1440x1080px · captured with the Natus RetCam Envision (130° field of view) · wide-field fundus photograph from neonatal ROP screening
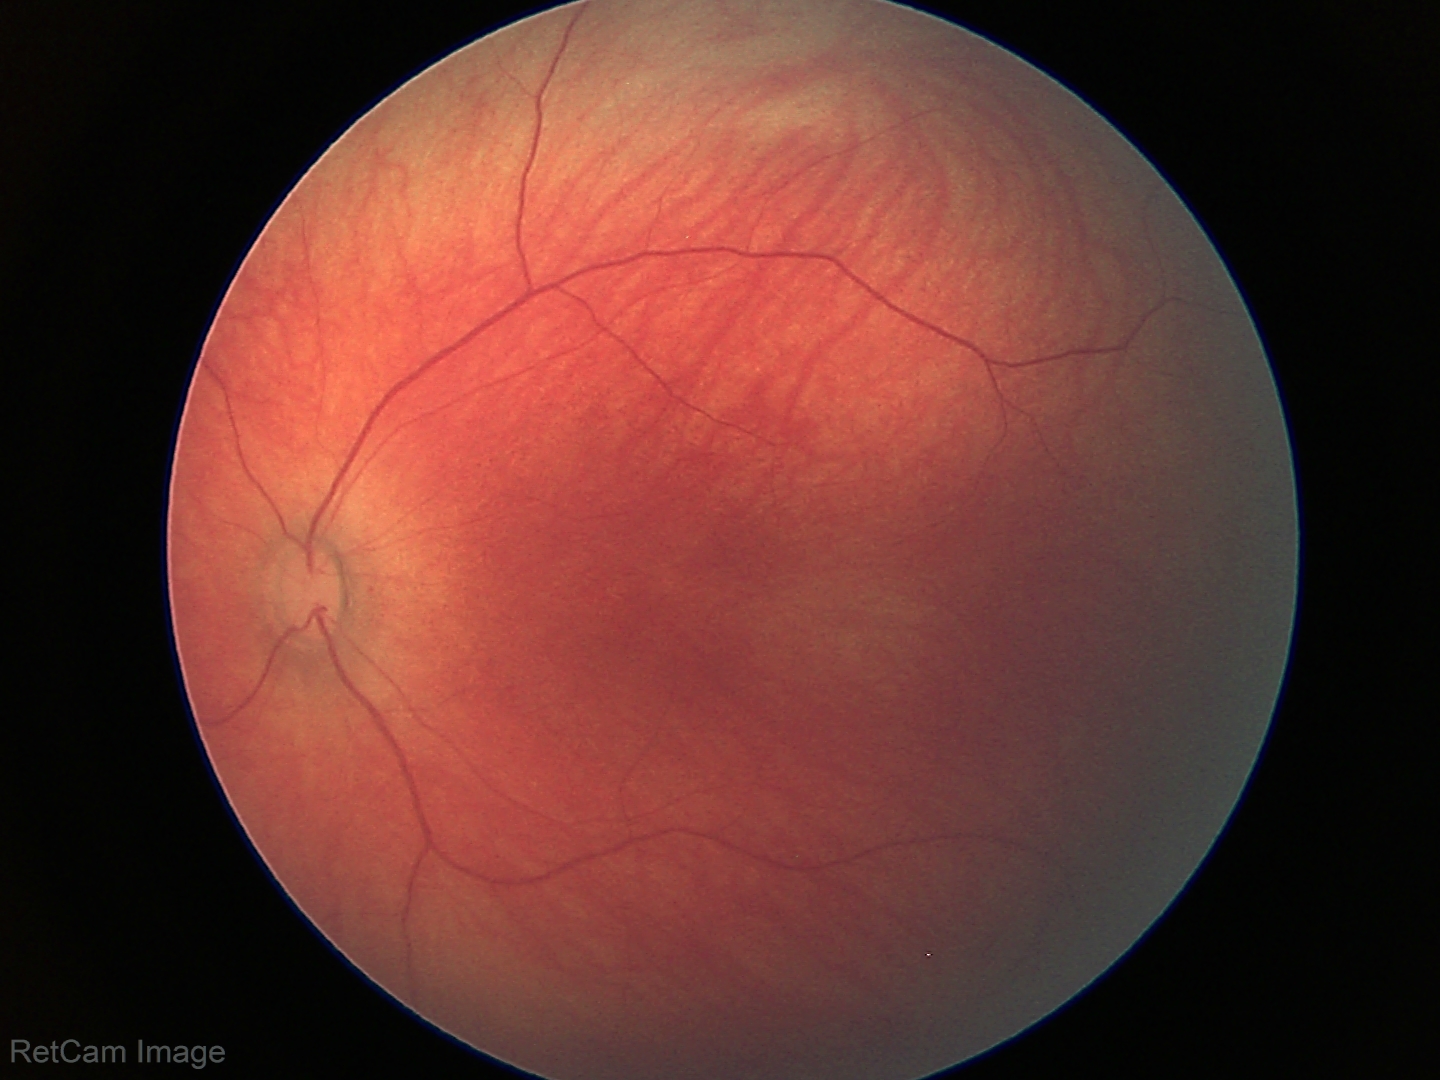
Impression: normal retinal appearance.